ONH-centered crop from a color fundus image. 376 x 376 pixels
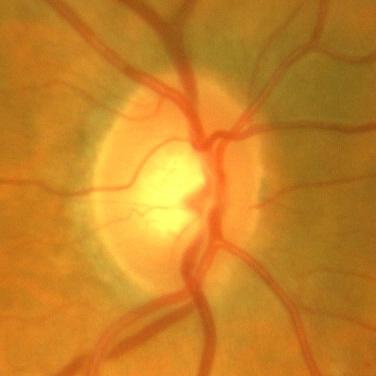 Impression = no signs of glaucoma.